45-degree field of view, camera: NIDEK AFC-230.
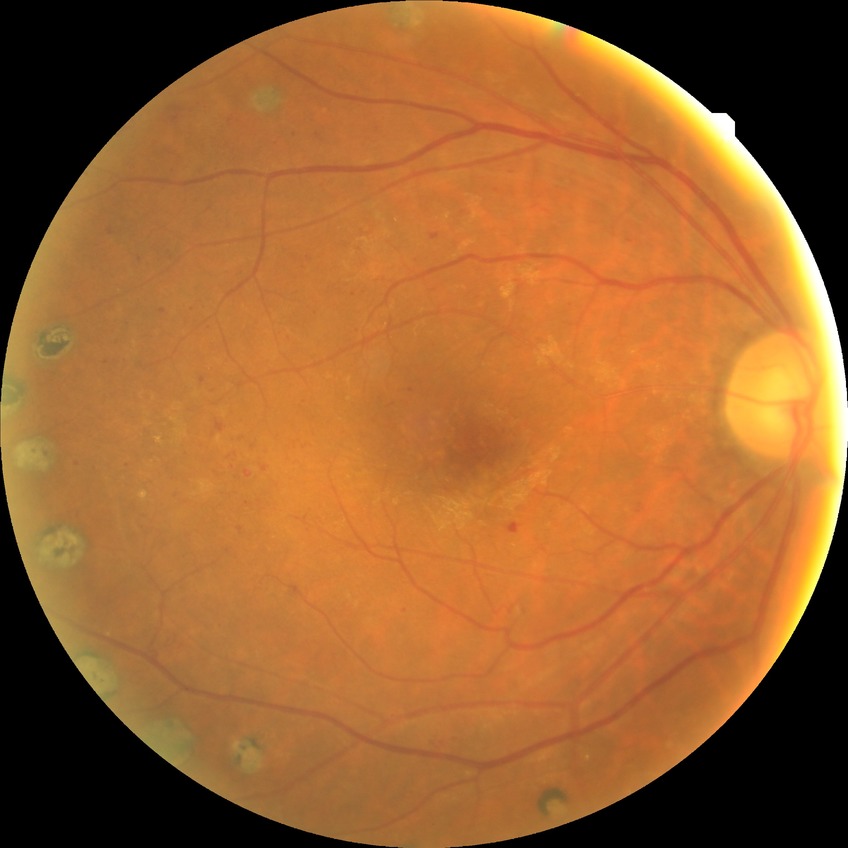
Retinopathy stage: proliferative diabetic retinopathy.